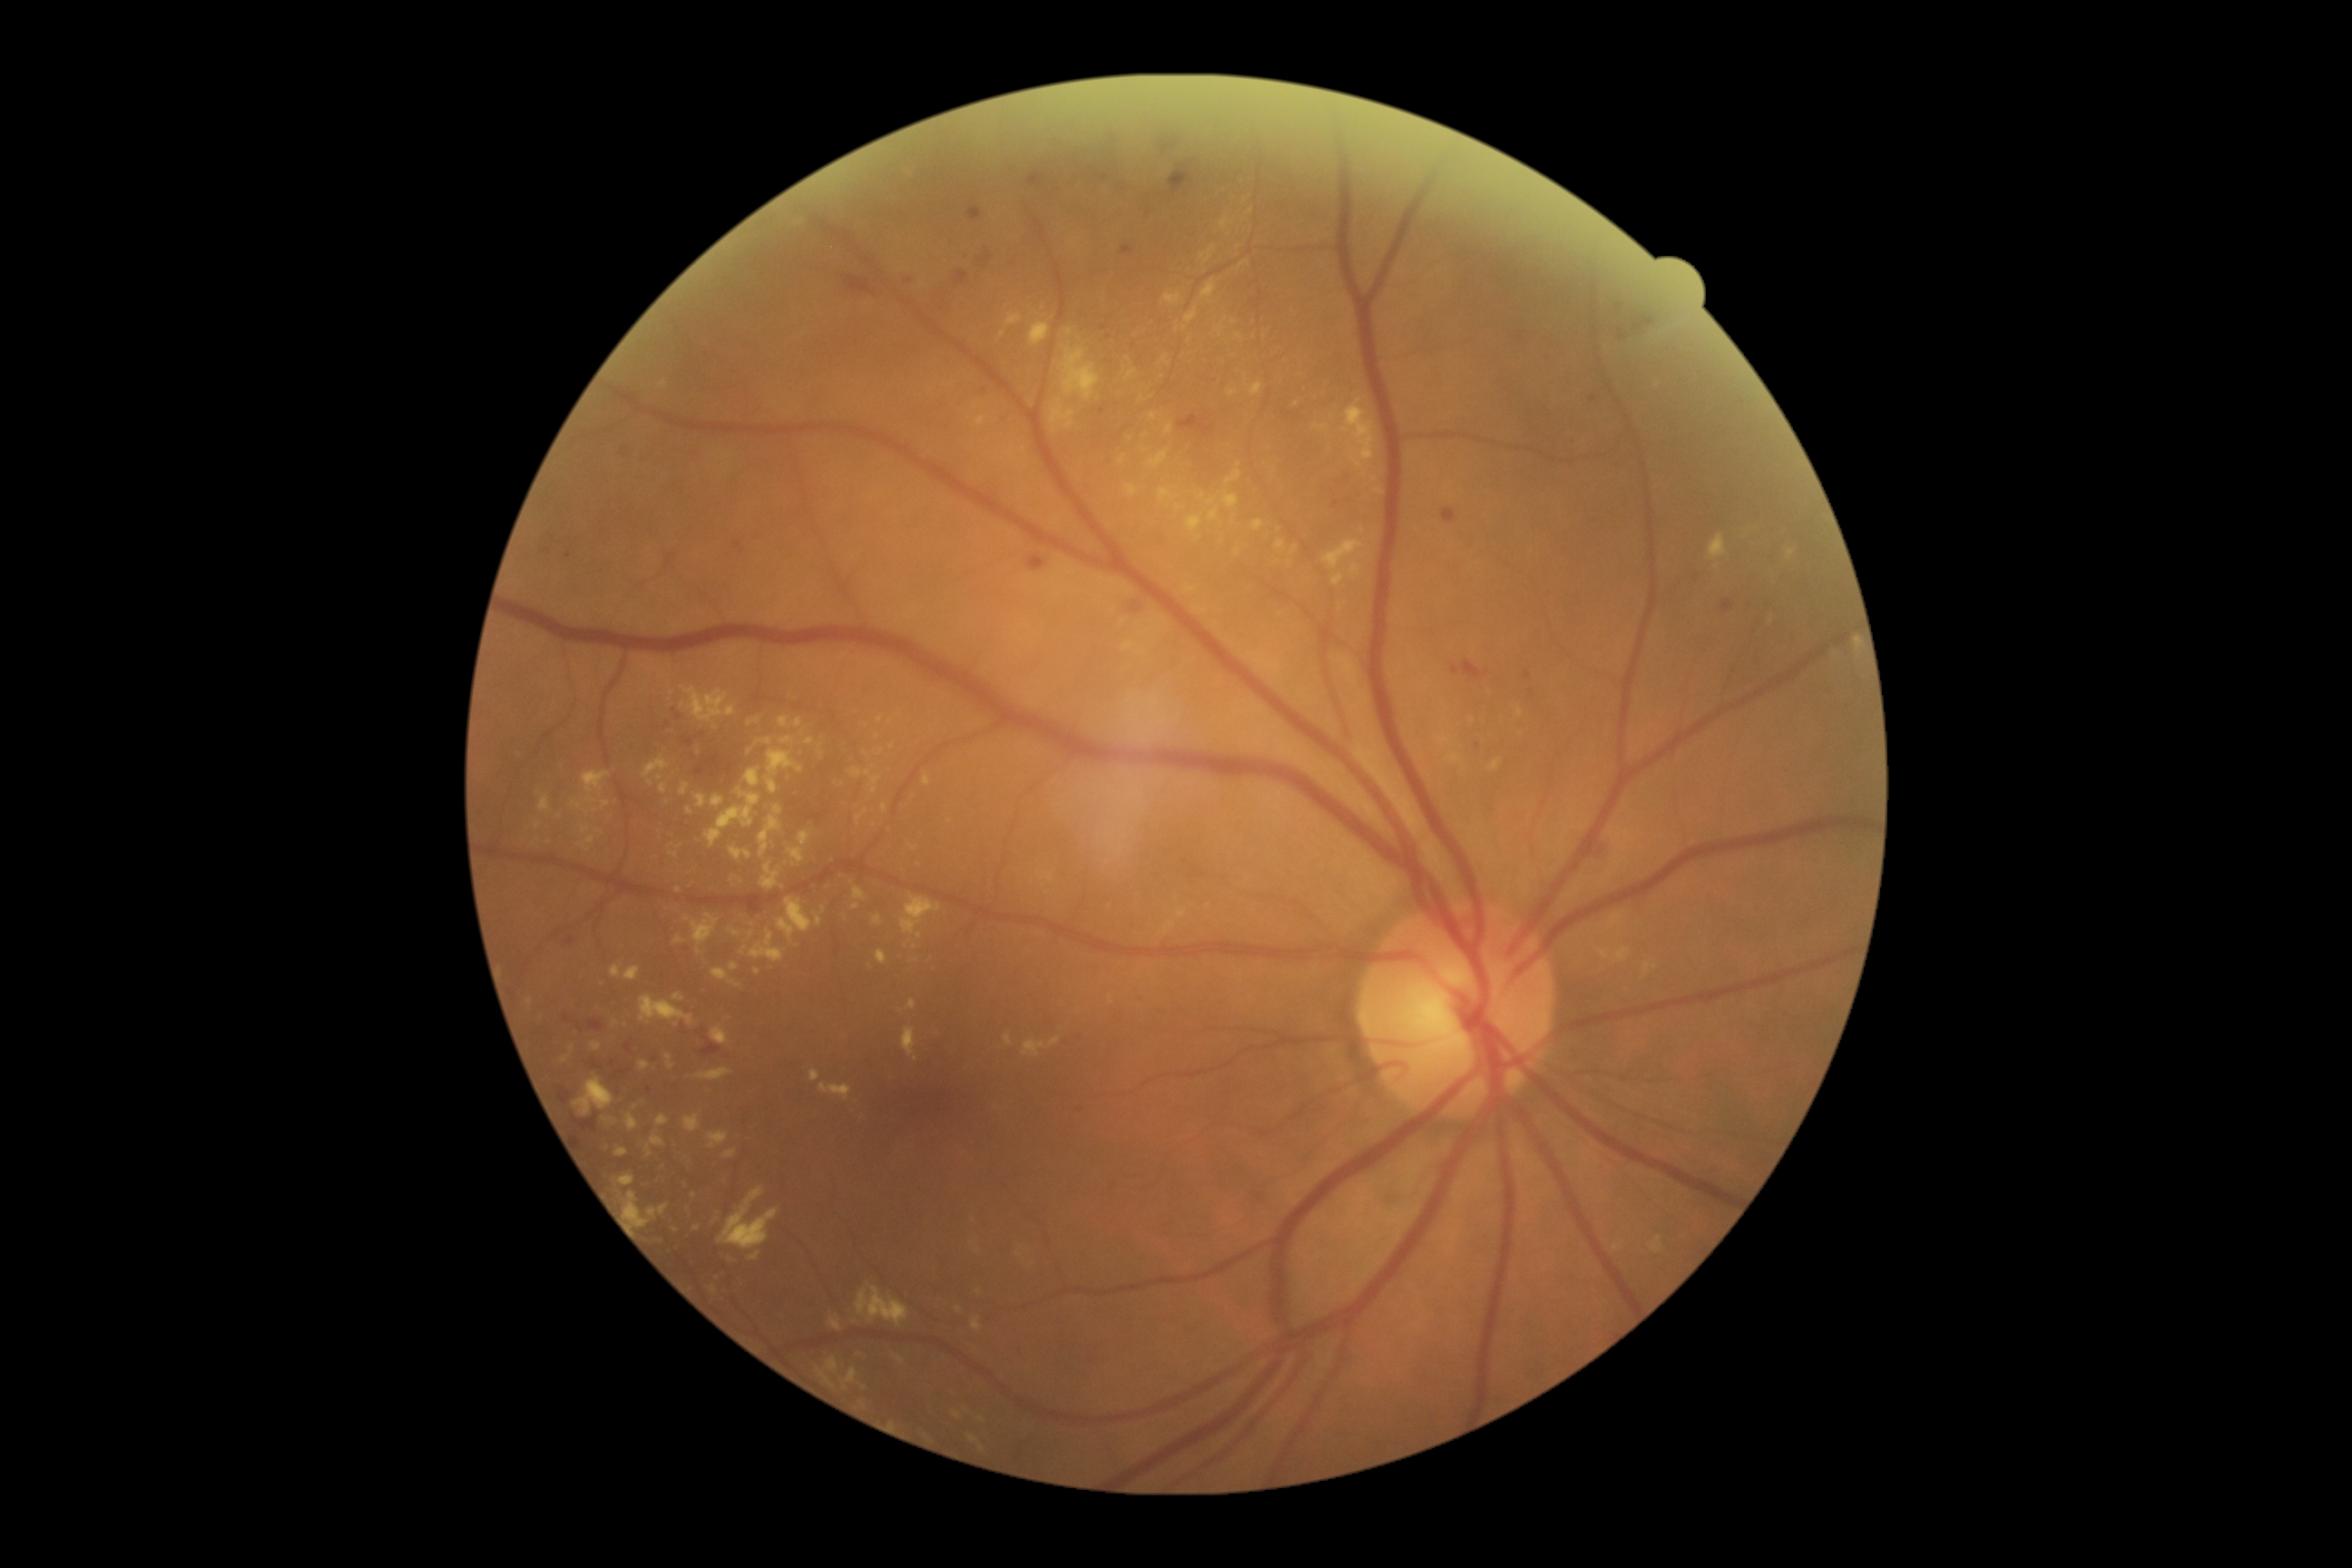 Diabetic retinopathy (DR): 2
Representative lesions:
• hard exudates (EXs) (subset): left=1643, top=963, right=1658, bottom=974; left=749, top=718, right=761, bottom=725; left=625, top=968, right=642, bottom=981; left=816, top=914, right=821, bottom=926; left=1331, top=573, right=1344, bottom=587; left=787, top=848, right=805, bottom=863; left=591, top=1041, right=602, bottom=1052; left=740, top=946, right=749, bottom=957; left=1342, top=398, right=1375, bottom=478; left=1023, top=1041, right=1048, bottom=1059; left=625, top=1191, right=651, bottom=1230
• Small EXs near pt(561, 816); pt(697, 1228); pt(1238, 552); pt(609, 1149); pt(870, 968); pt(951, 822); pt(590, 841); pt(1239, 465)